71-year-old patient · axial length 22 mm · corneal thickness: 571 µm · refraction: +3.75 -1.5 × 79° · captured on a Topcon TRC-NW400 fundus camera — 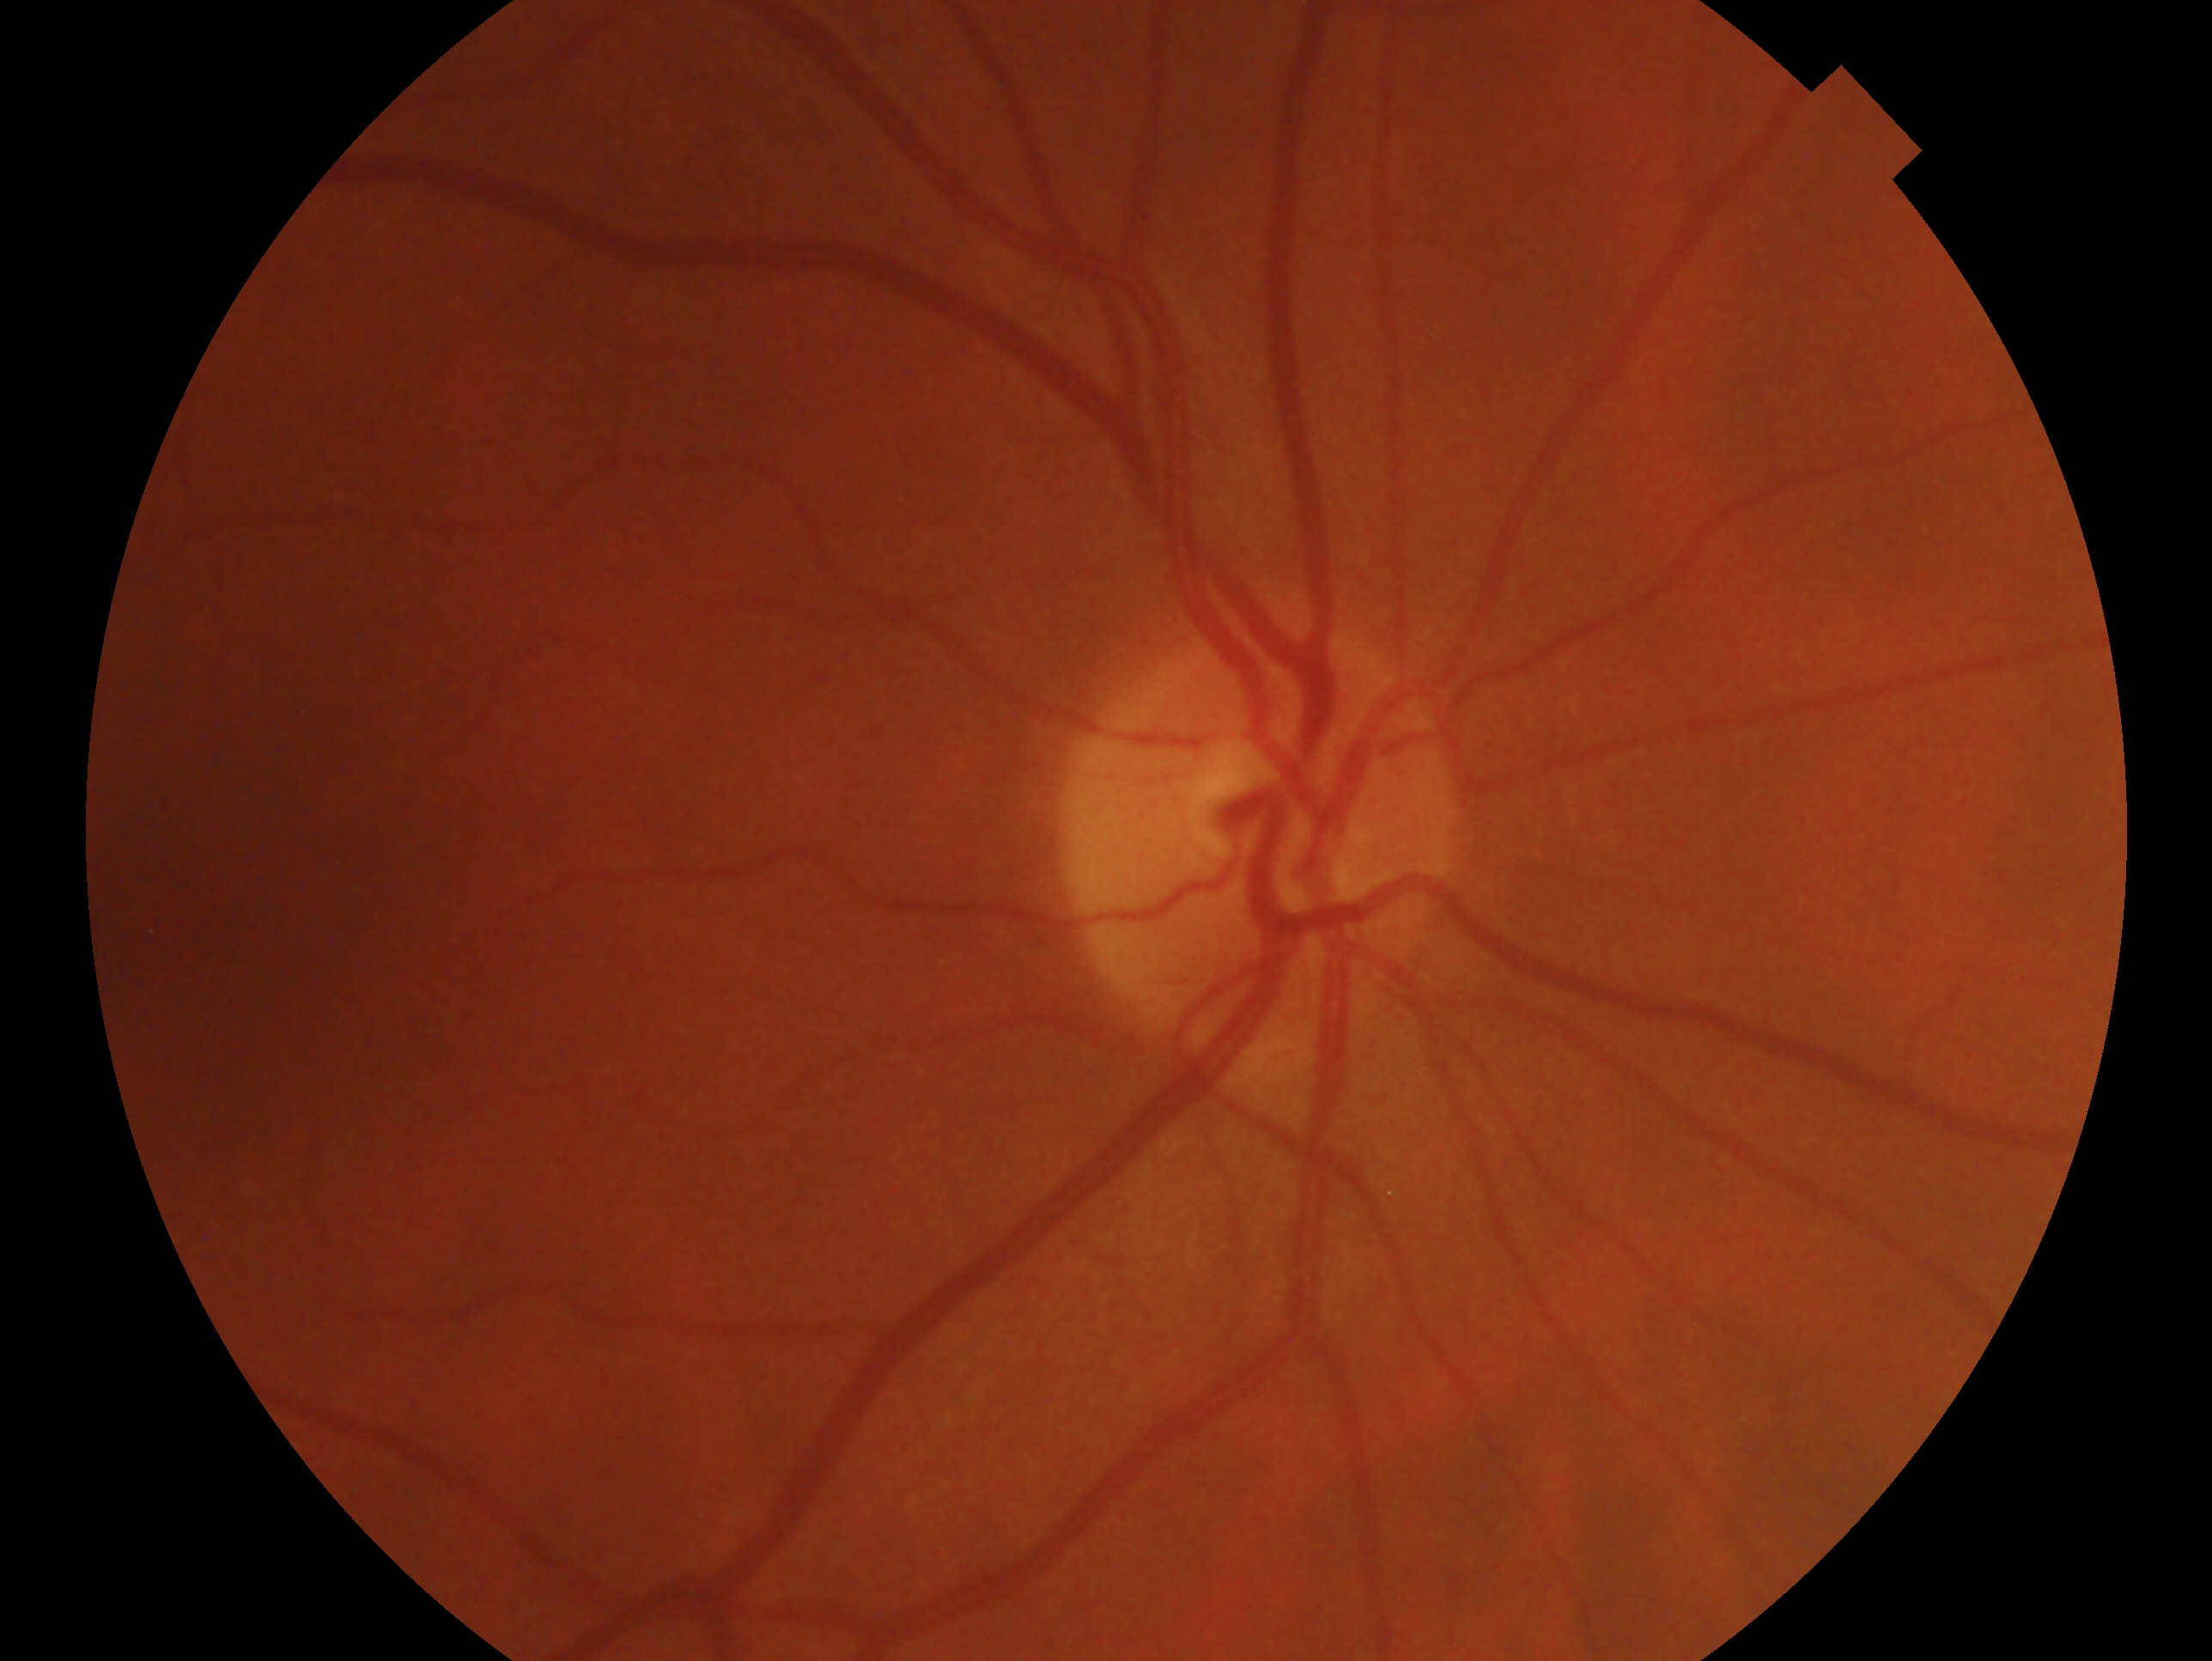
Eye: OD. Diagnosis: no glaucoma — no clinical evidence of glaucoma in this eye.